1504x1000: 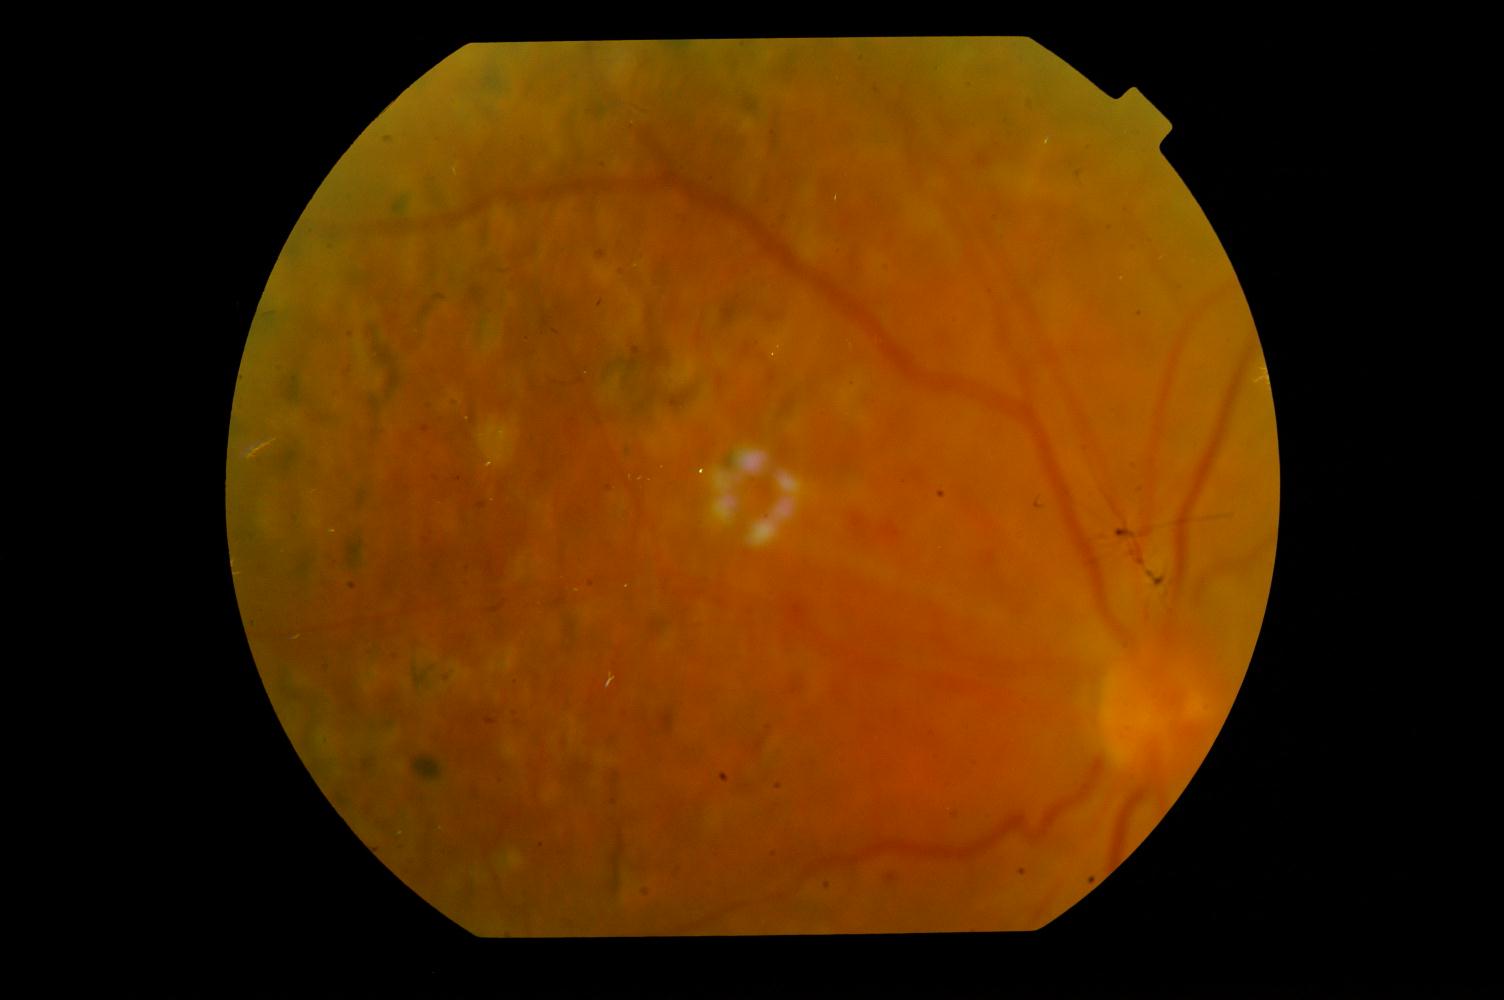

Findings consistent with diabetic retinopathy.